45° FOV · posterior pole color fundus photograph · NIDEK AFC-230 · 848 by 848 pixels:
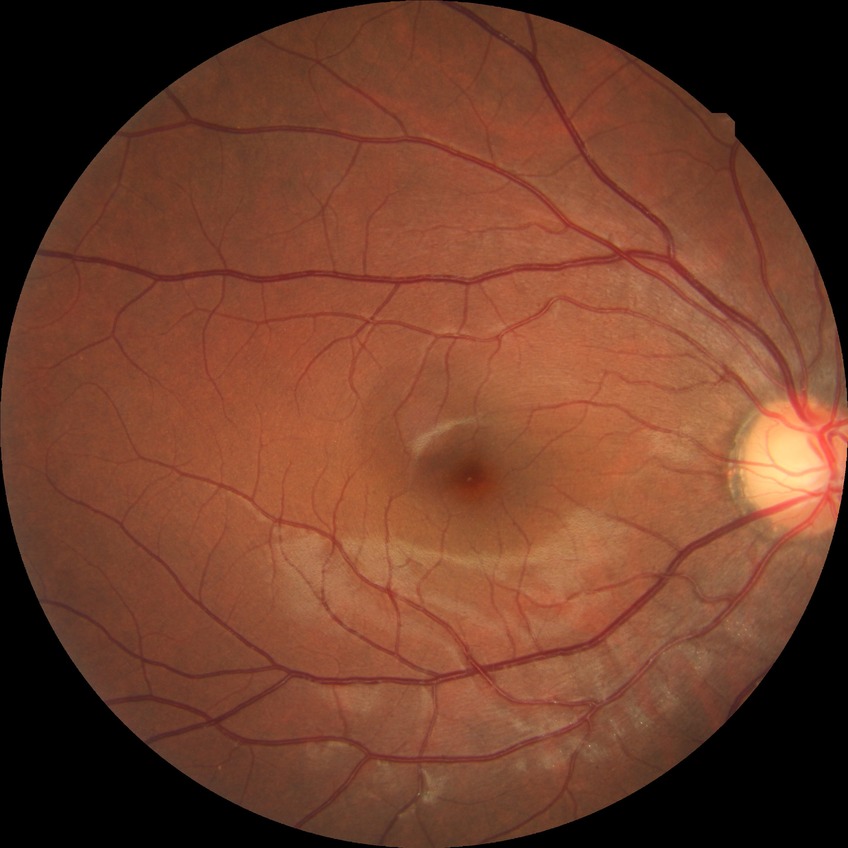
diabetic retinopathy (DR) = no diabetic retinopathy (NDR)